Pediatric wide-field fundus photograph · captured with the Natus RetCam Envision (130° field of view) · image size 1440x1080.
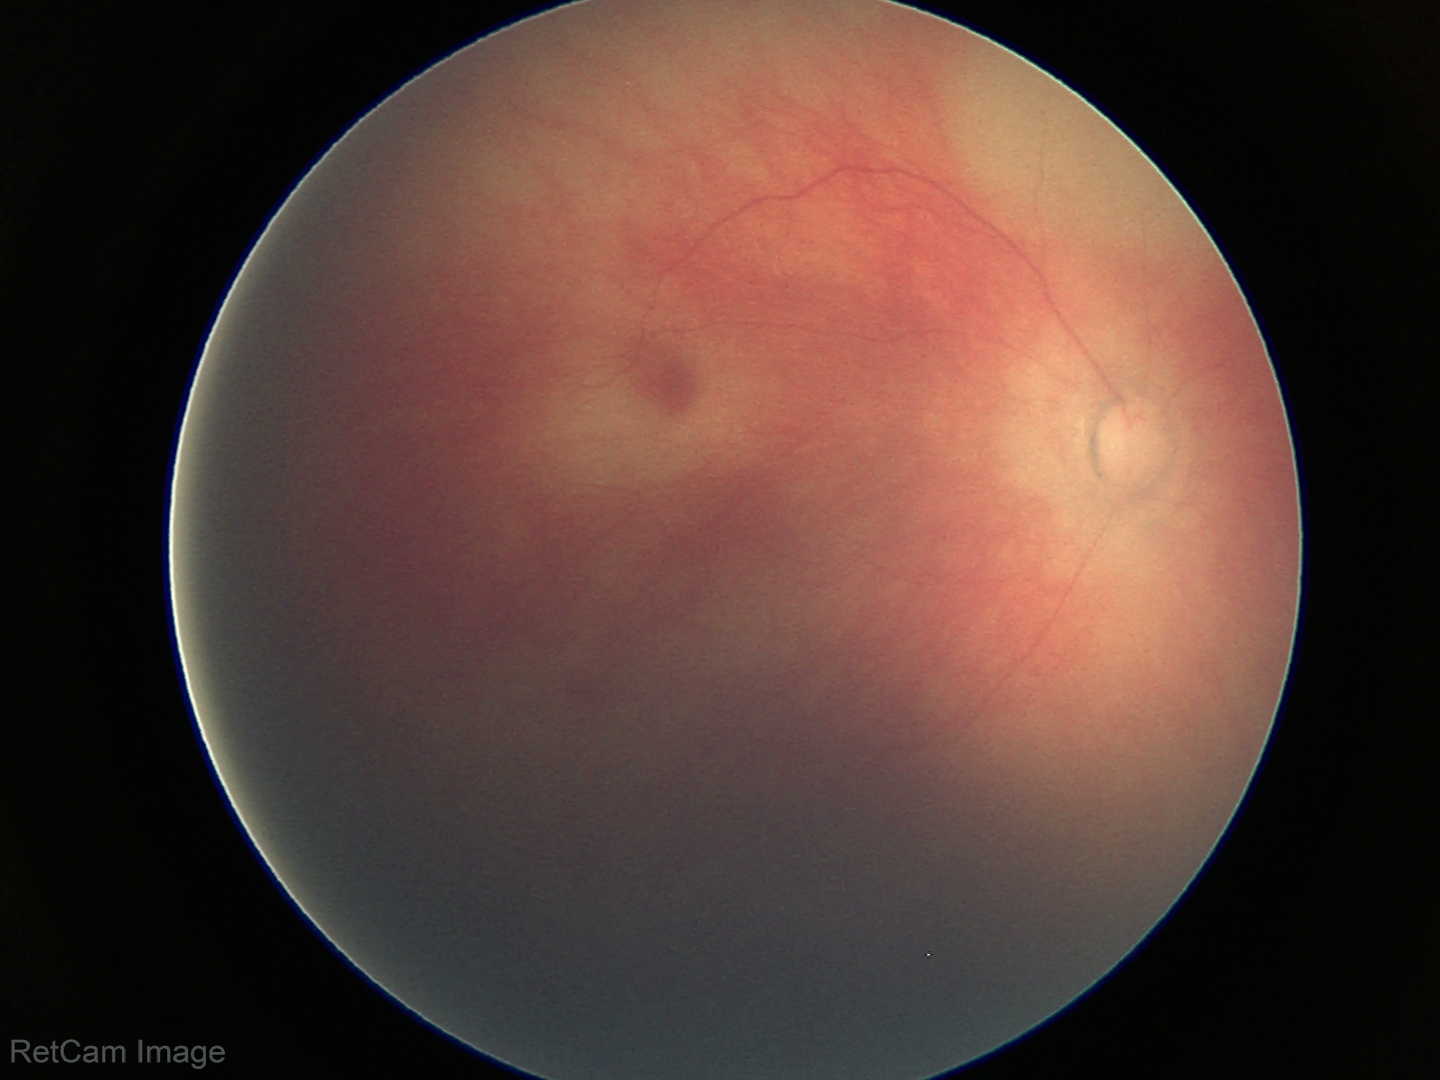
Physiological retinal appearance for postconceptual age.